45° FOV; 2352 by 1568 pixels: 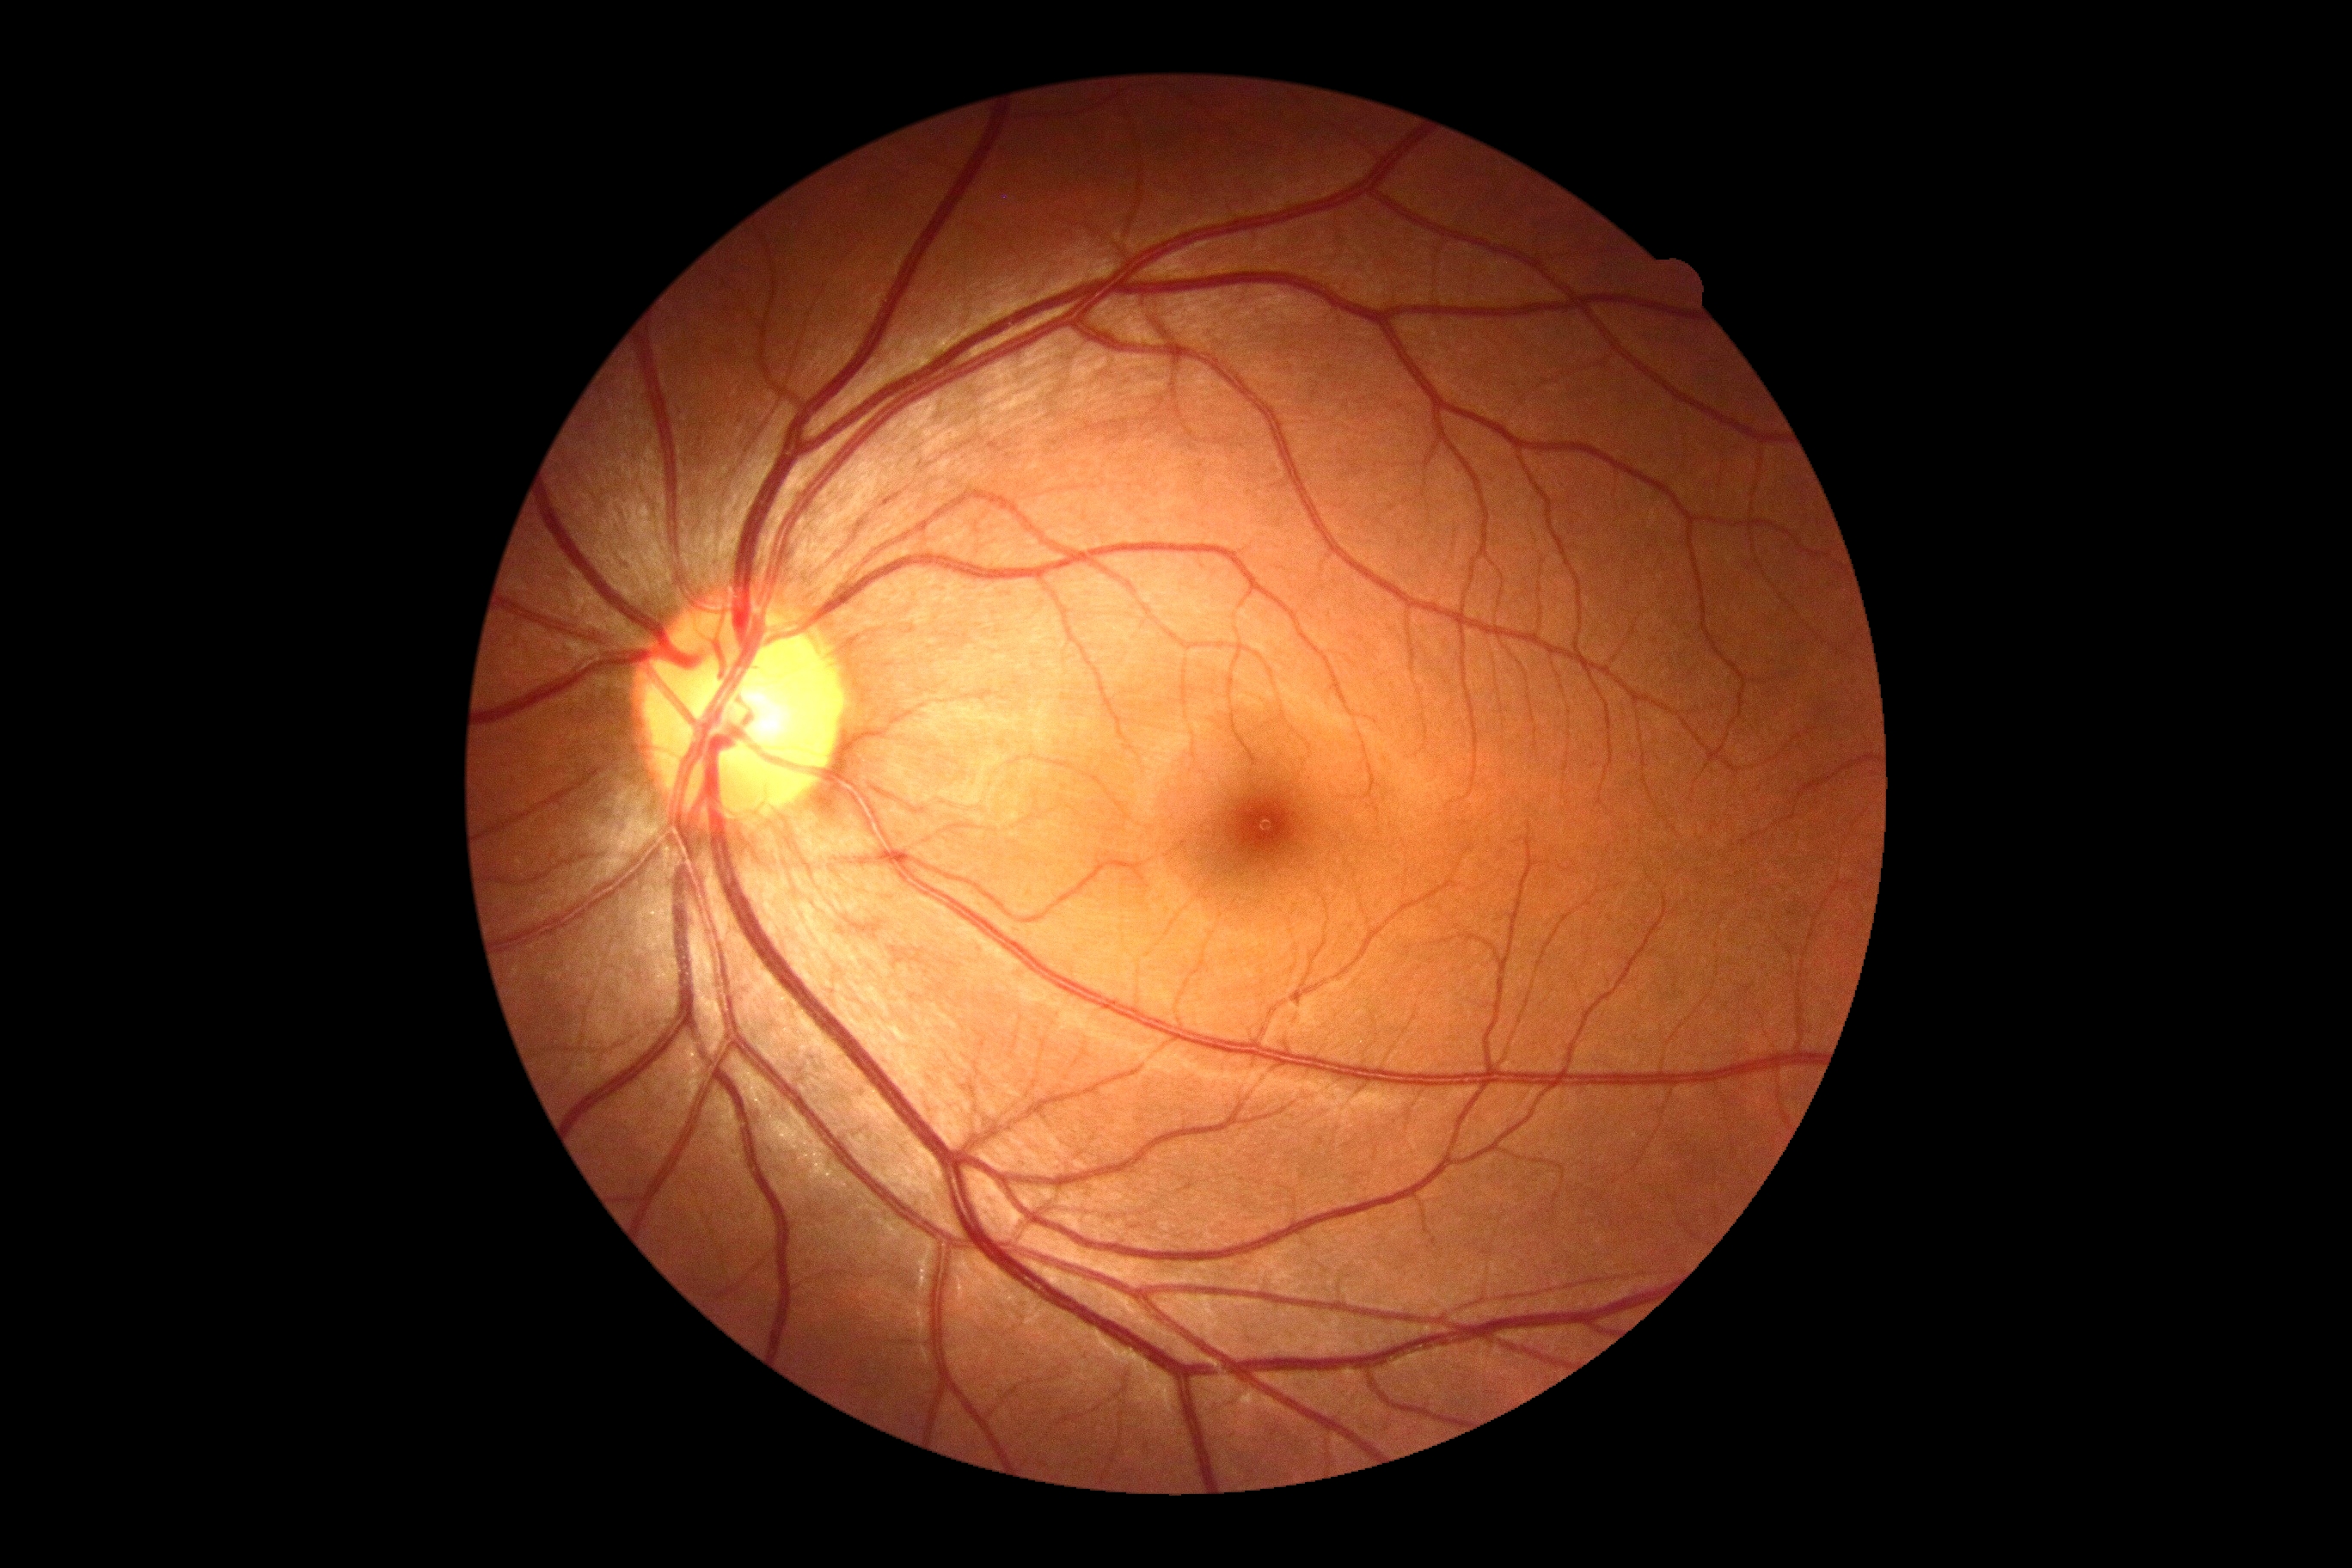

Diabetic retinopathy severity: 0 — no visible signs of diabetic retinopathy. No DR findings.